Acquired with a NIDEK AFC-230:
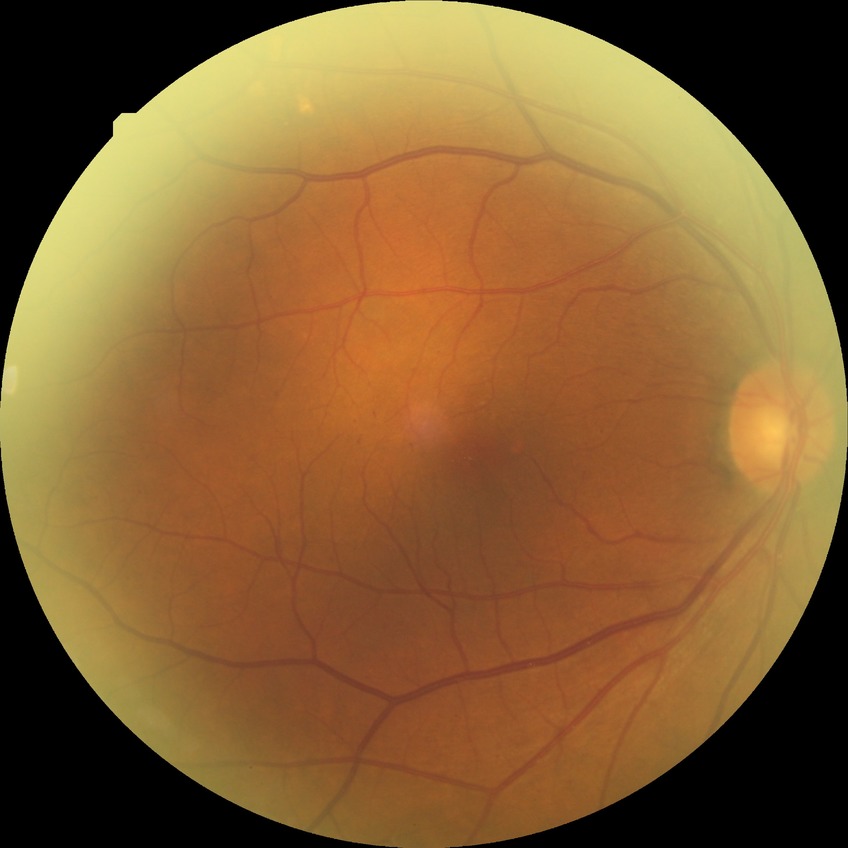

* DR class: non-proliferative diabetic retinopathy
* diabetic retinopathy (DR): simple diabetic retinopathy (SDR)